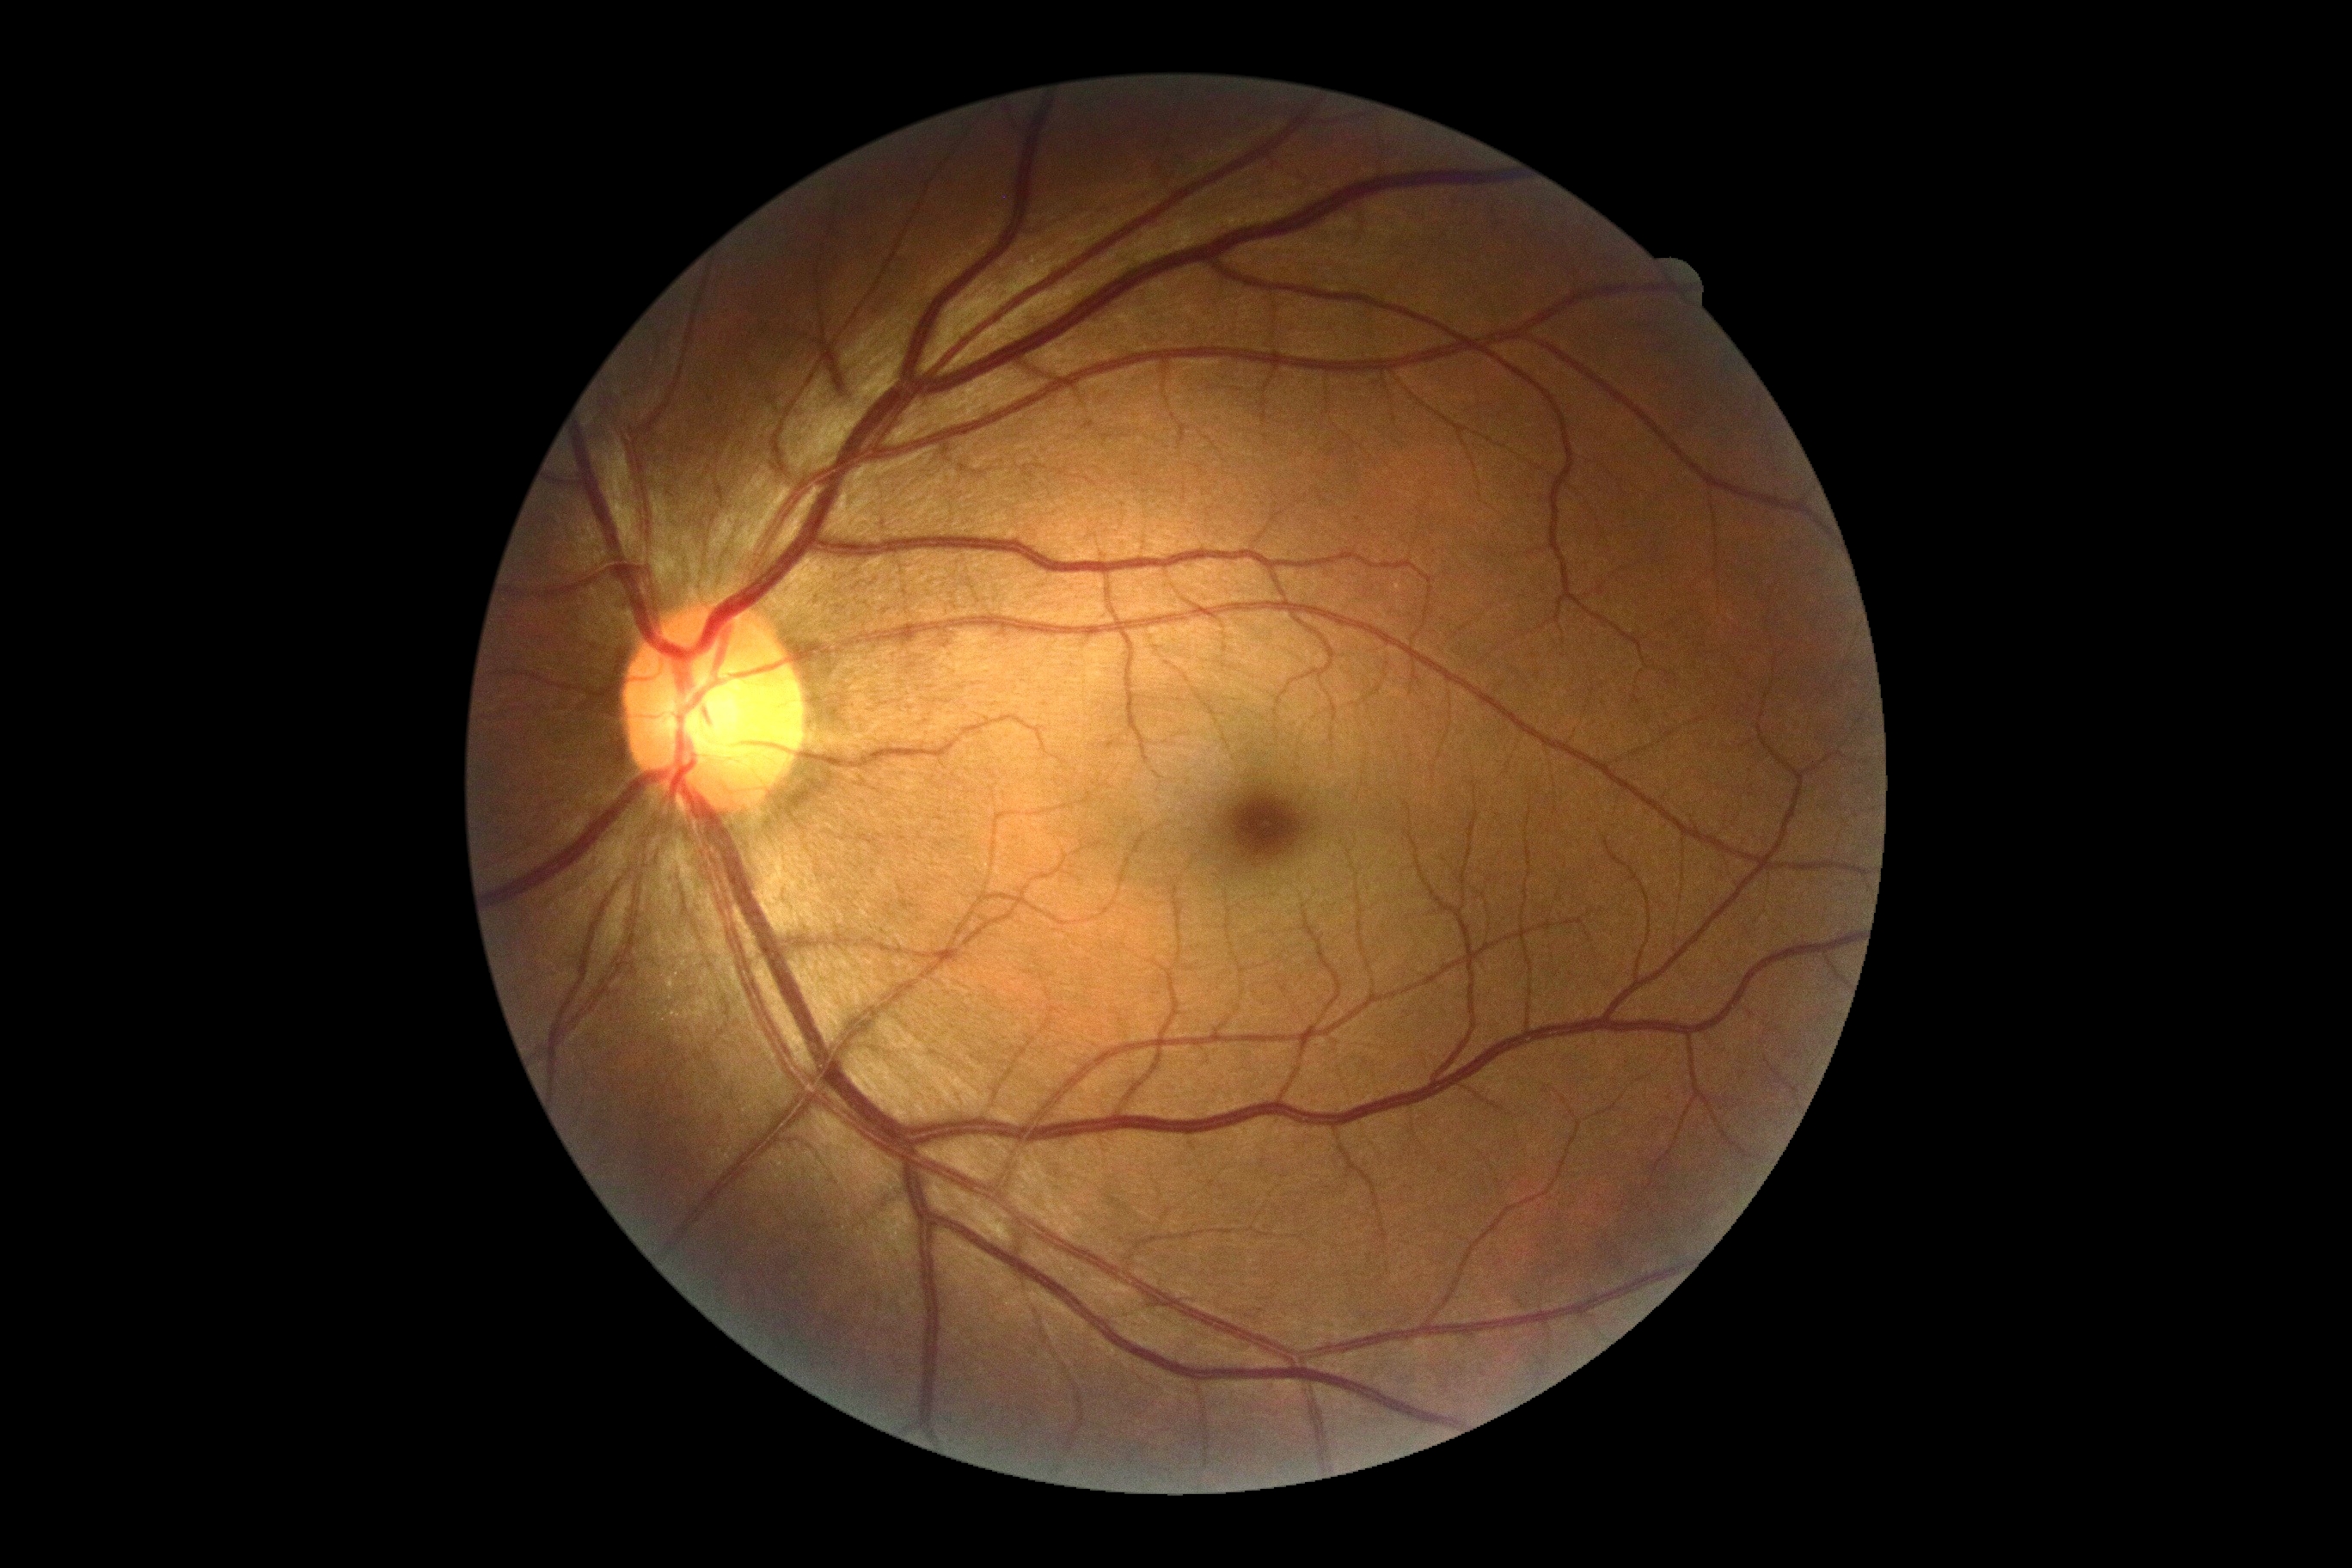
Diabetic retinopathy severity: grade 0 (no apparent retinopathy).
No diabetic retinal disease findings.